FOV: 50 degrees — 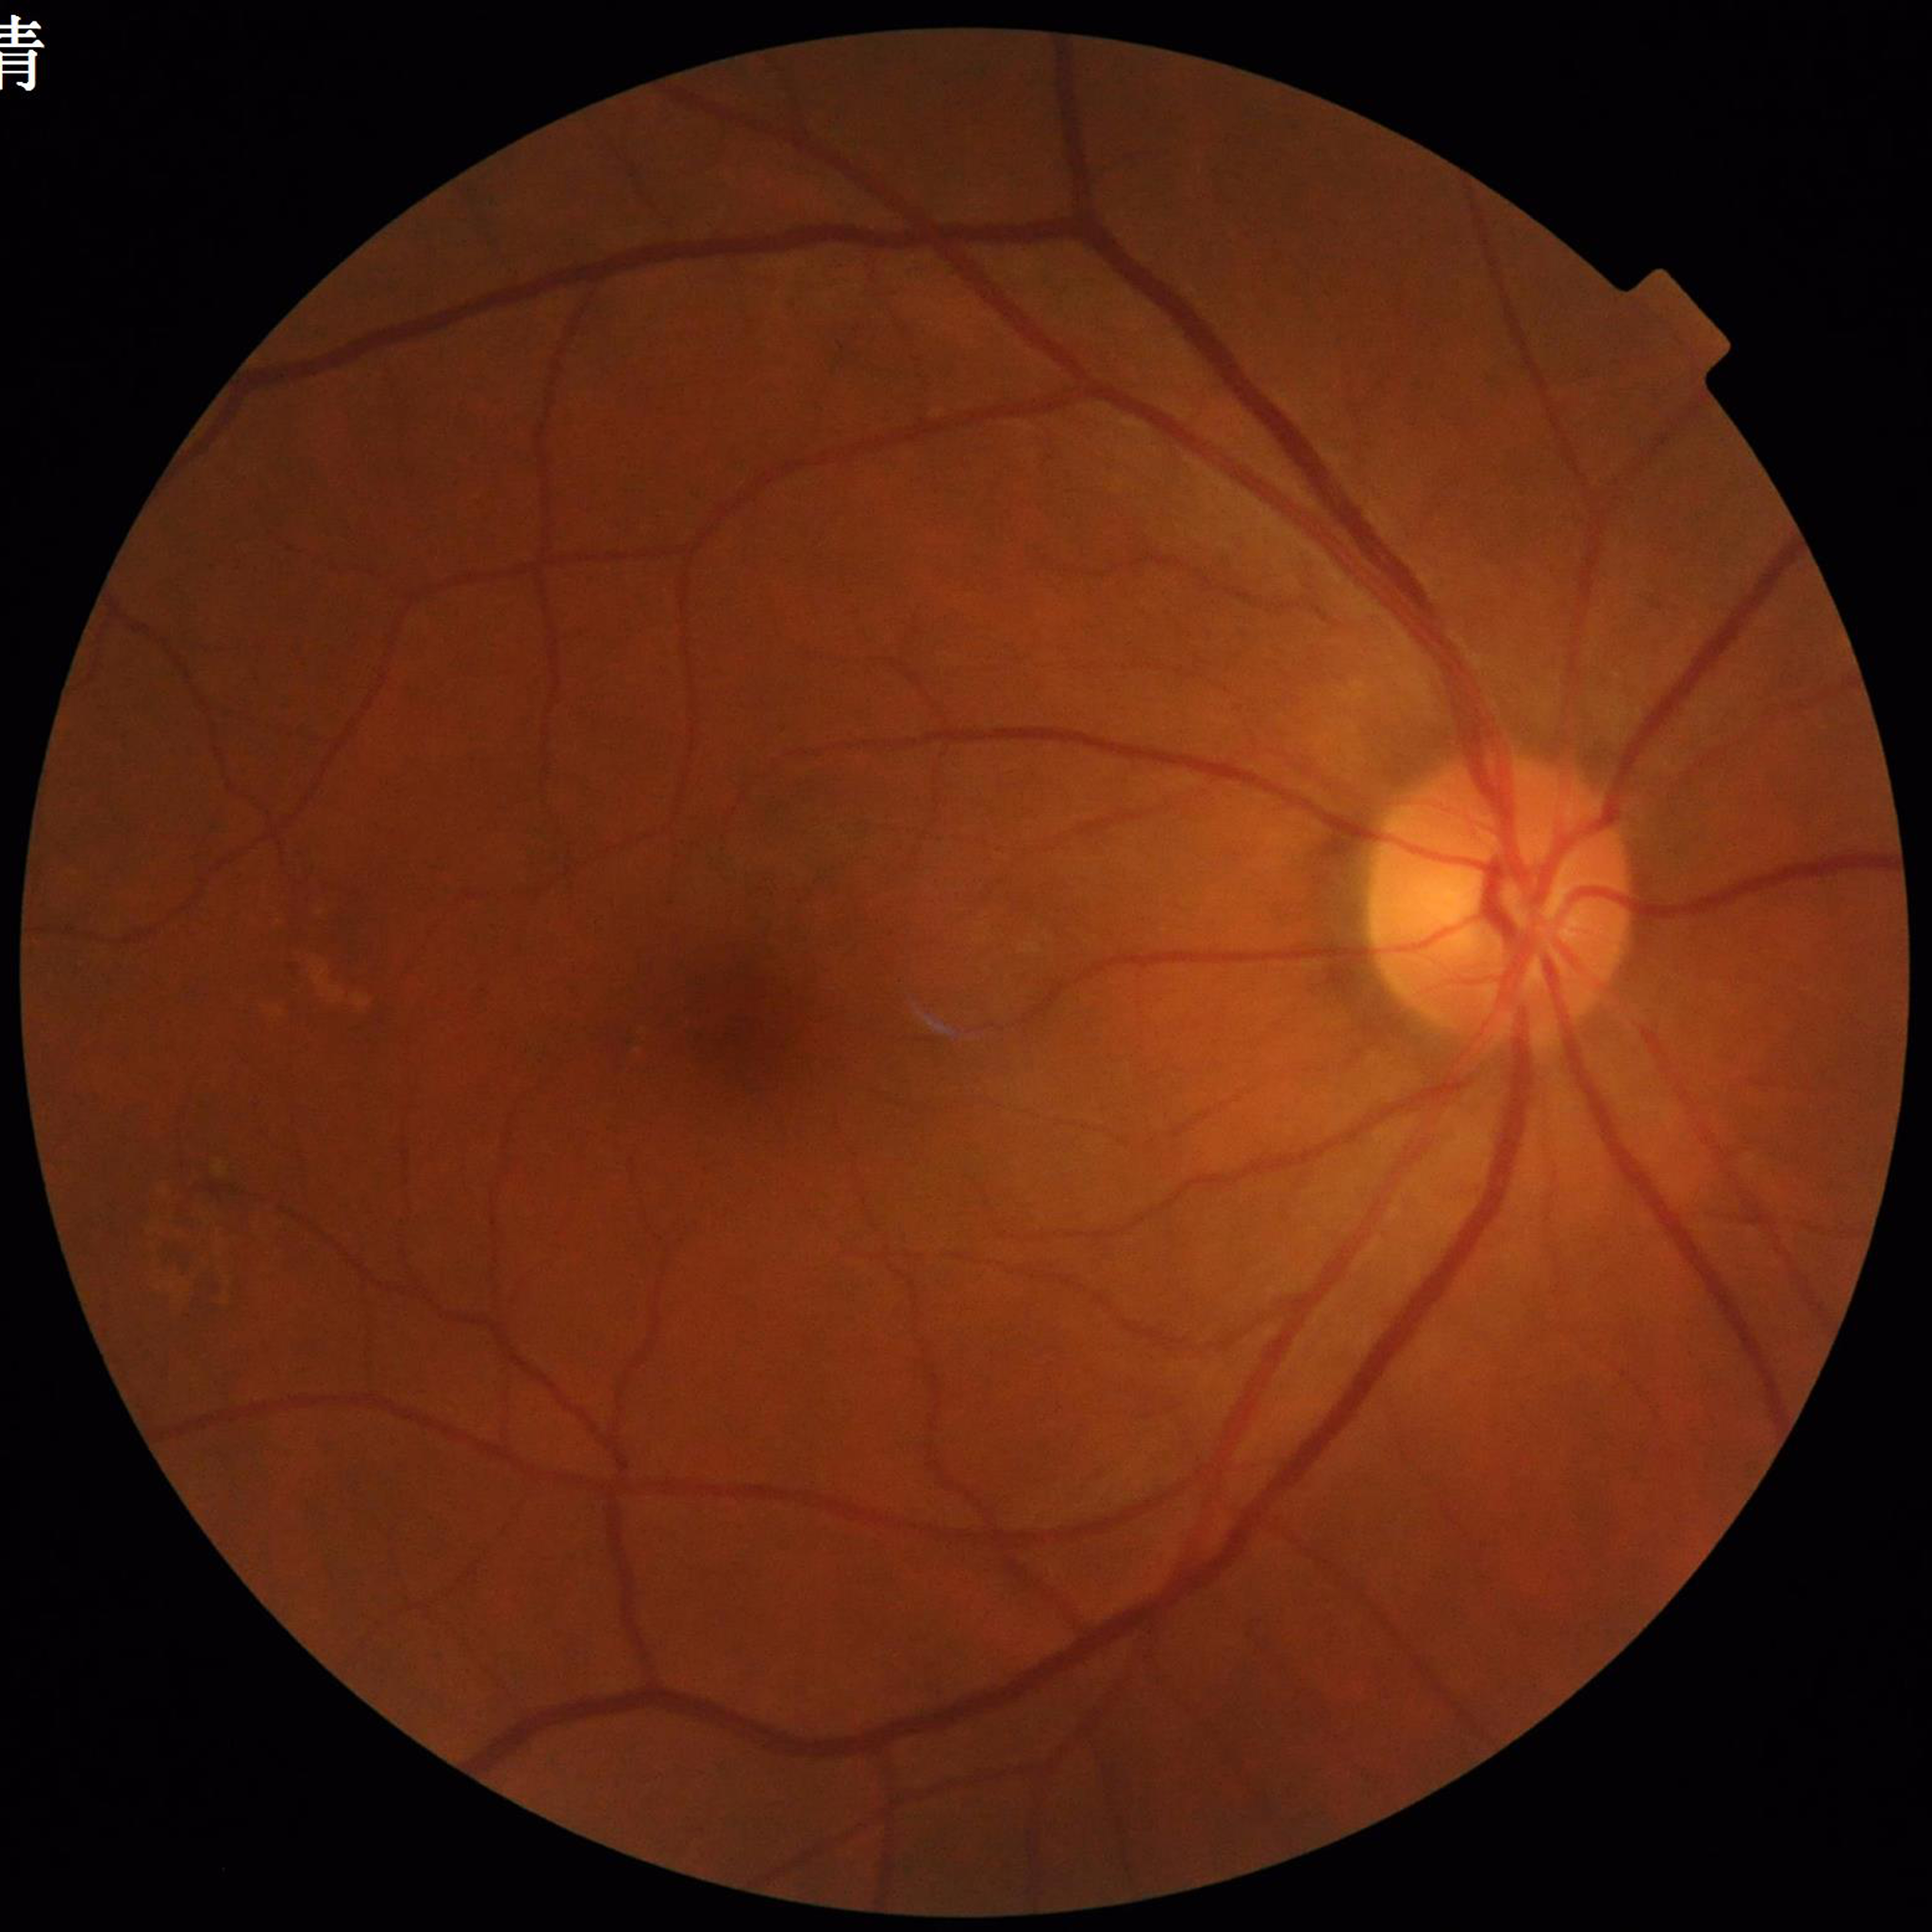

{
  "diagnosis": "AMD"
}